Image size 2048x1536: 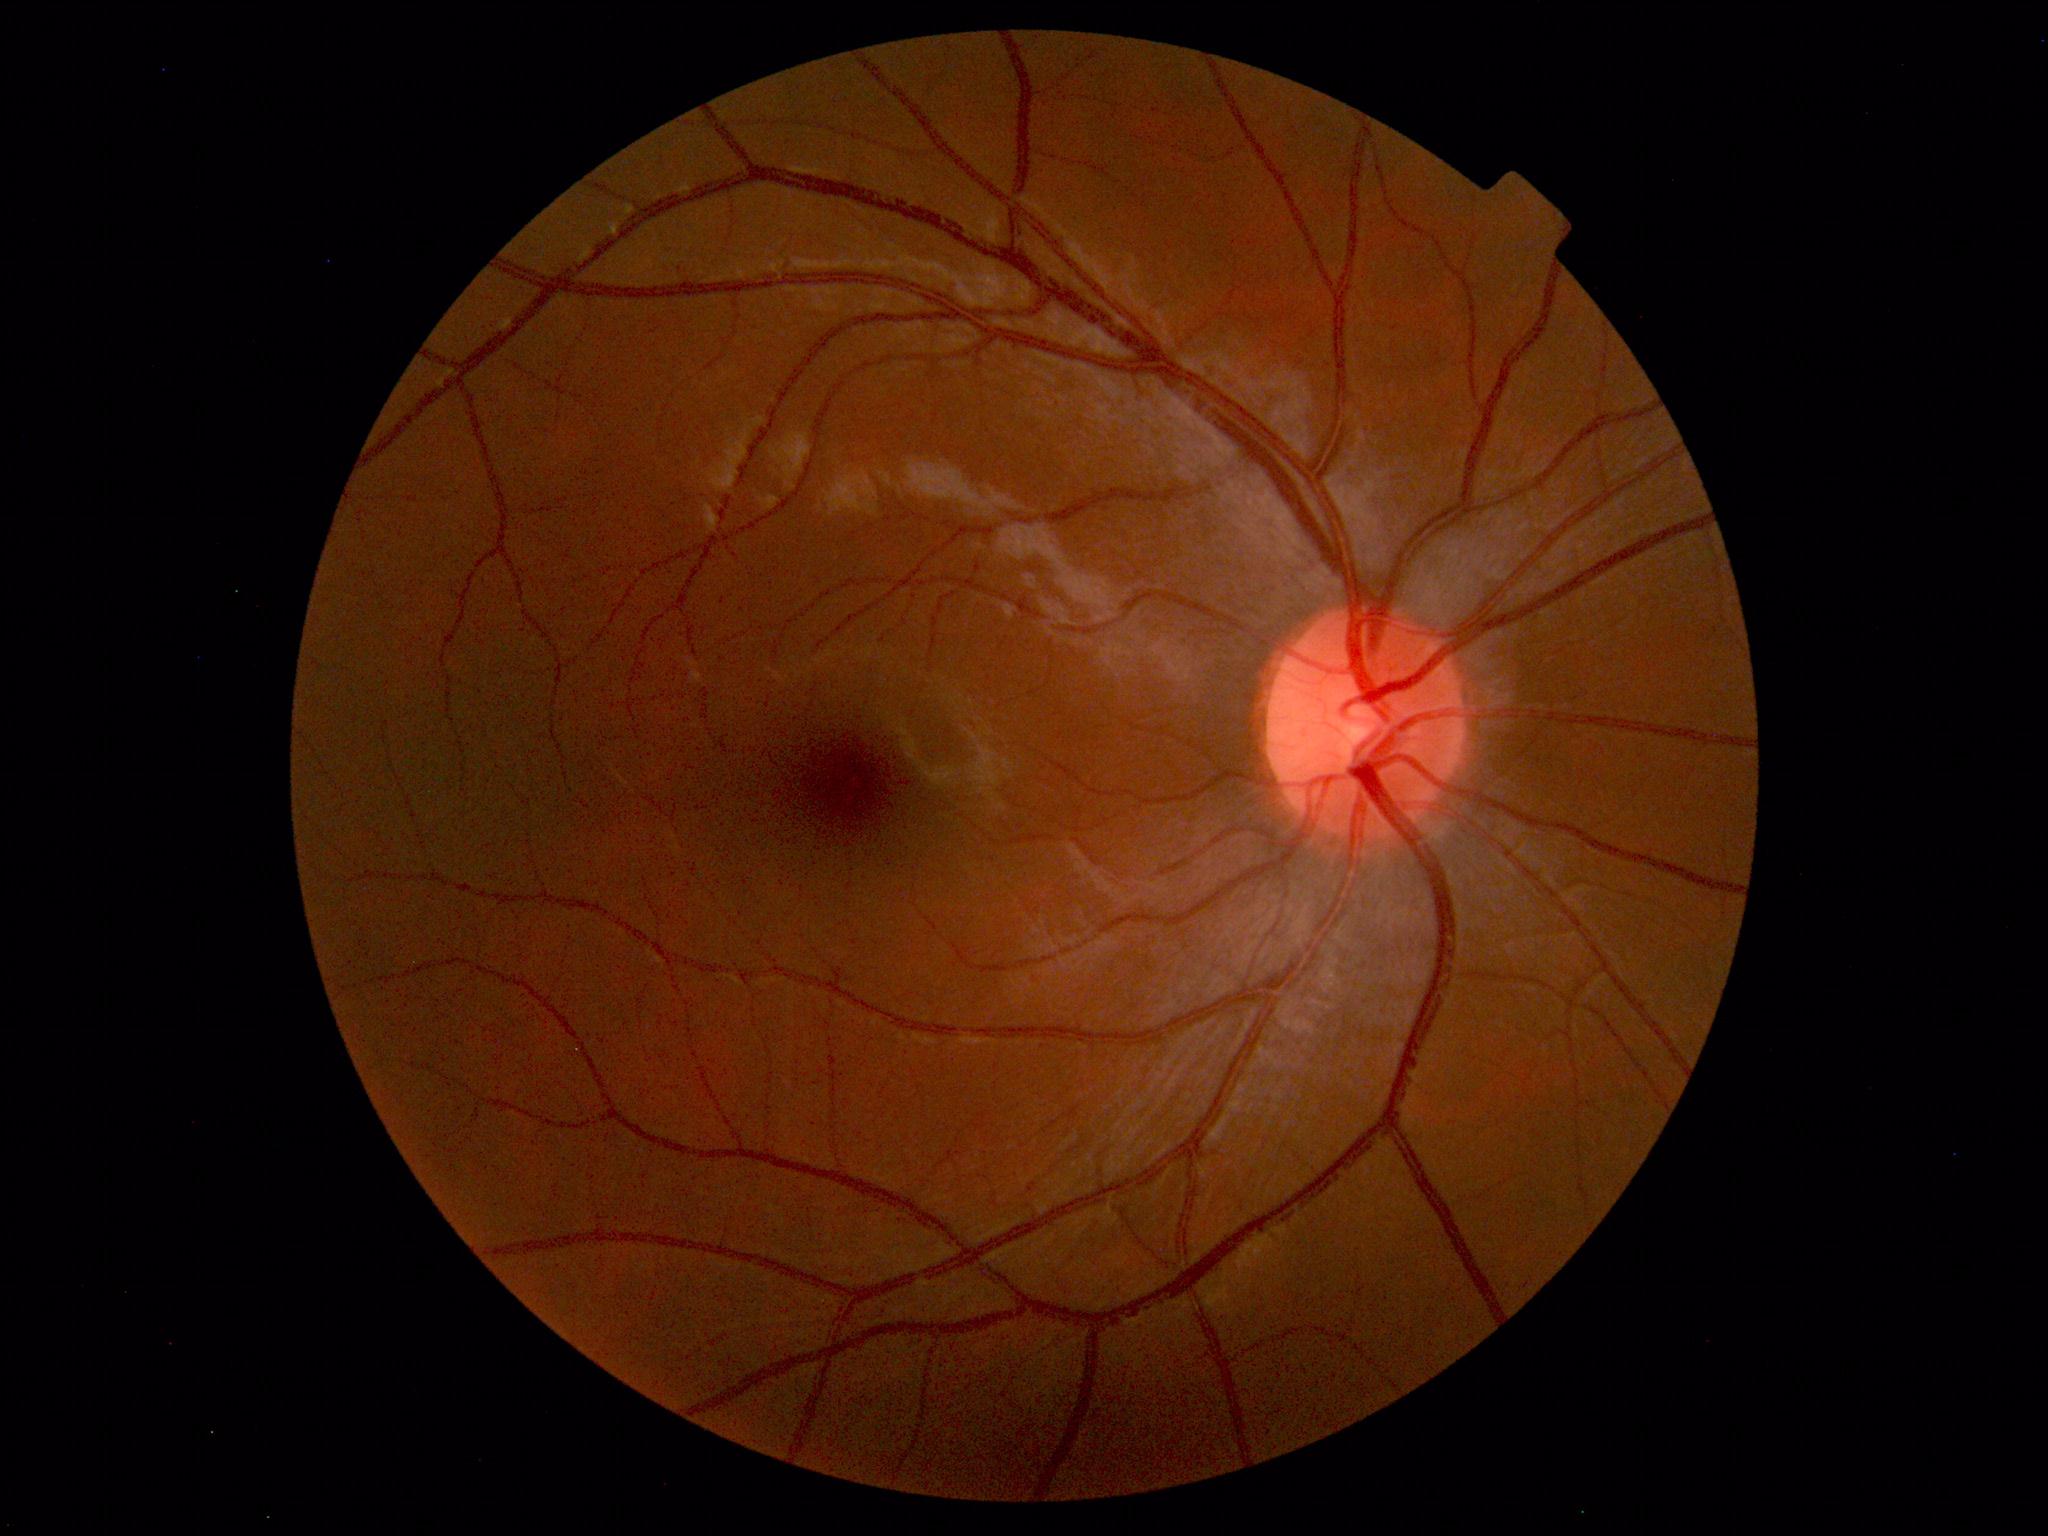

Within normal limits. No abnormalities identified.